45° FOV
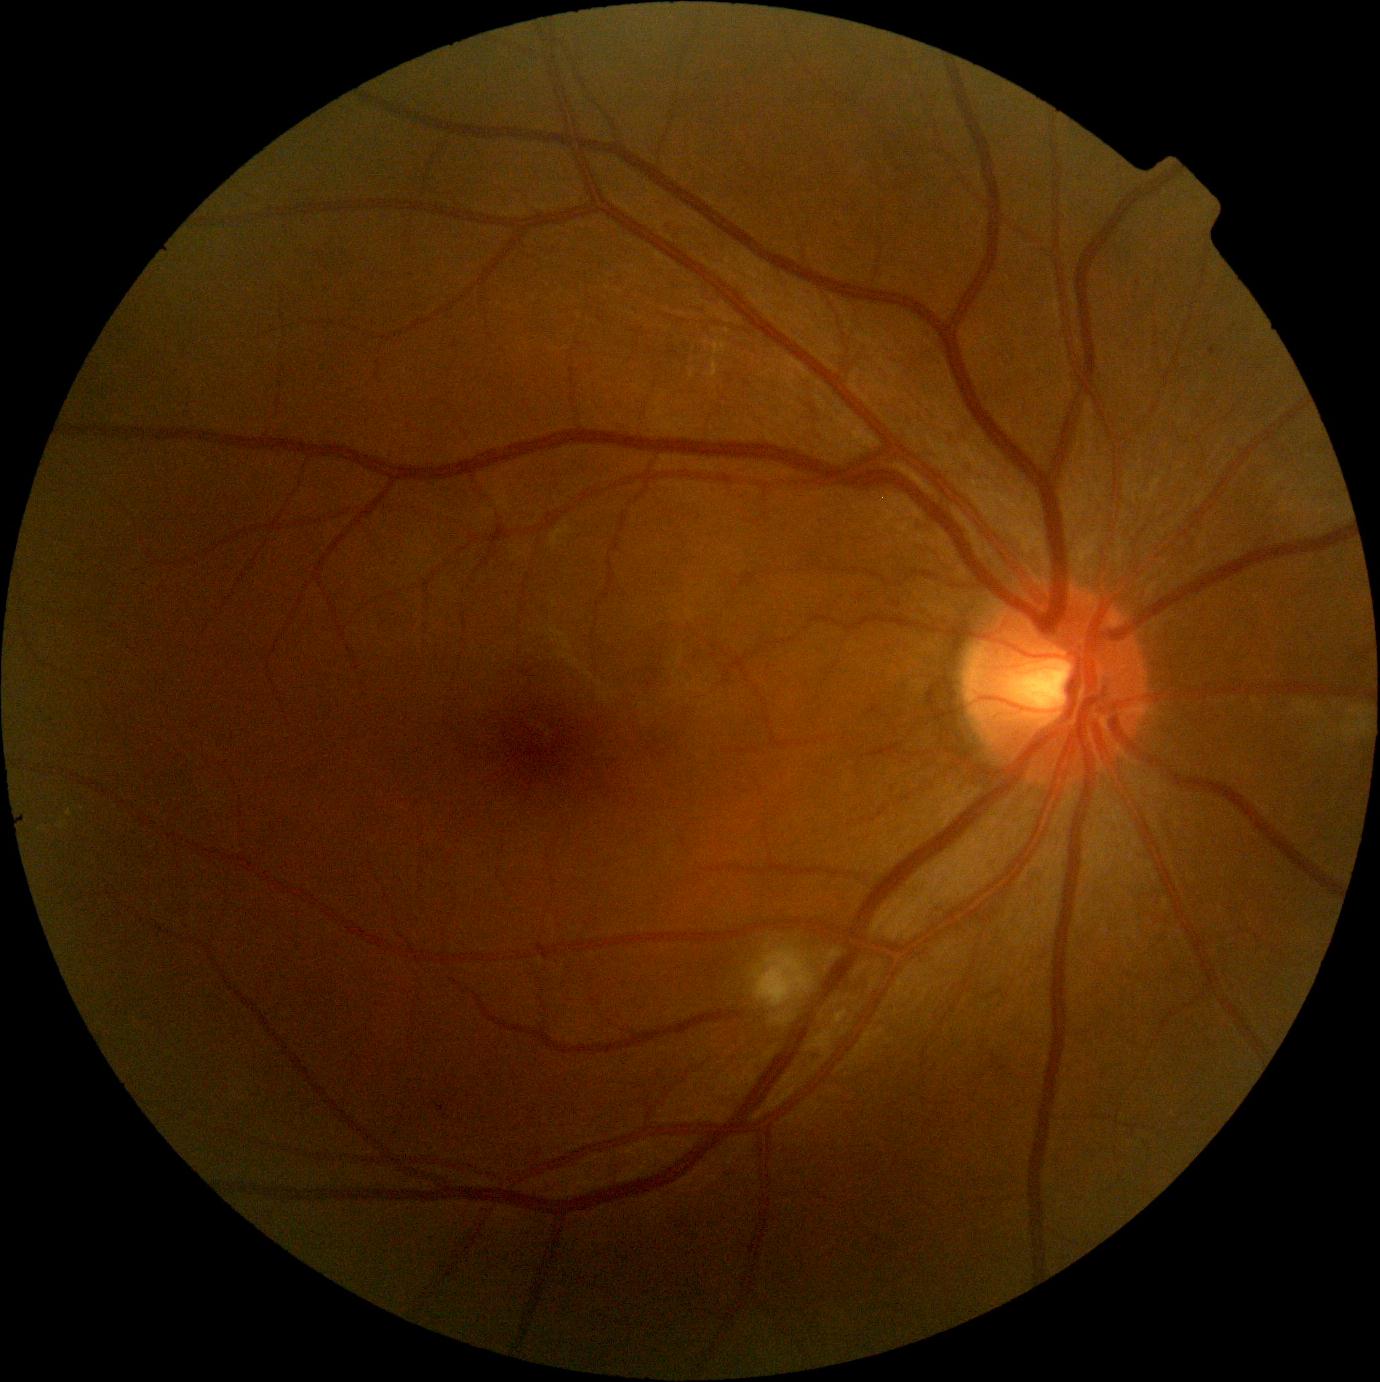 Diabetic retinopathy (DR): moderate non-proliferative diabetic retinopathy (grade 2)
hemorrhages (HEs): none detected
microaneurysms (MAs): <box>1209,348,1217,356</box>
soft exudates (SEs): <box>752,949,813,1008</box>
hard exudates (EXs): <box>711,340,729,355</box>; <box>60,821,65,829</box>; <box>67,809,73,817</box>; <box>710,359,719,378</box>